Posterior pole color fundus photograph:
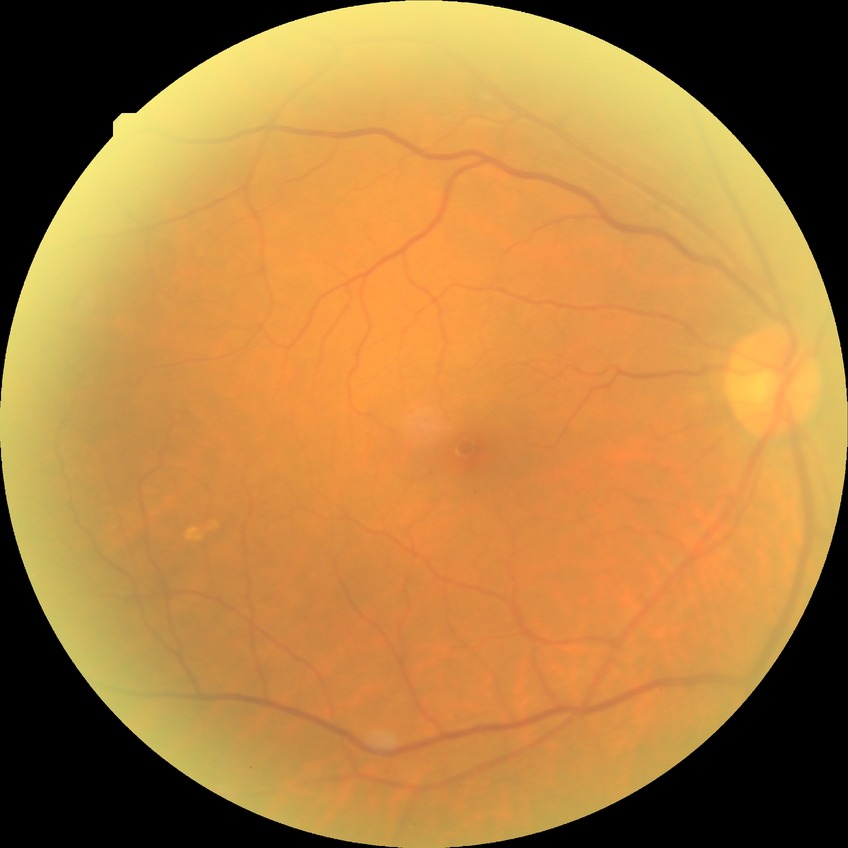

Diabetic retinopathy stage: no diabetic retinopathy.